Retinal fundus photograph — 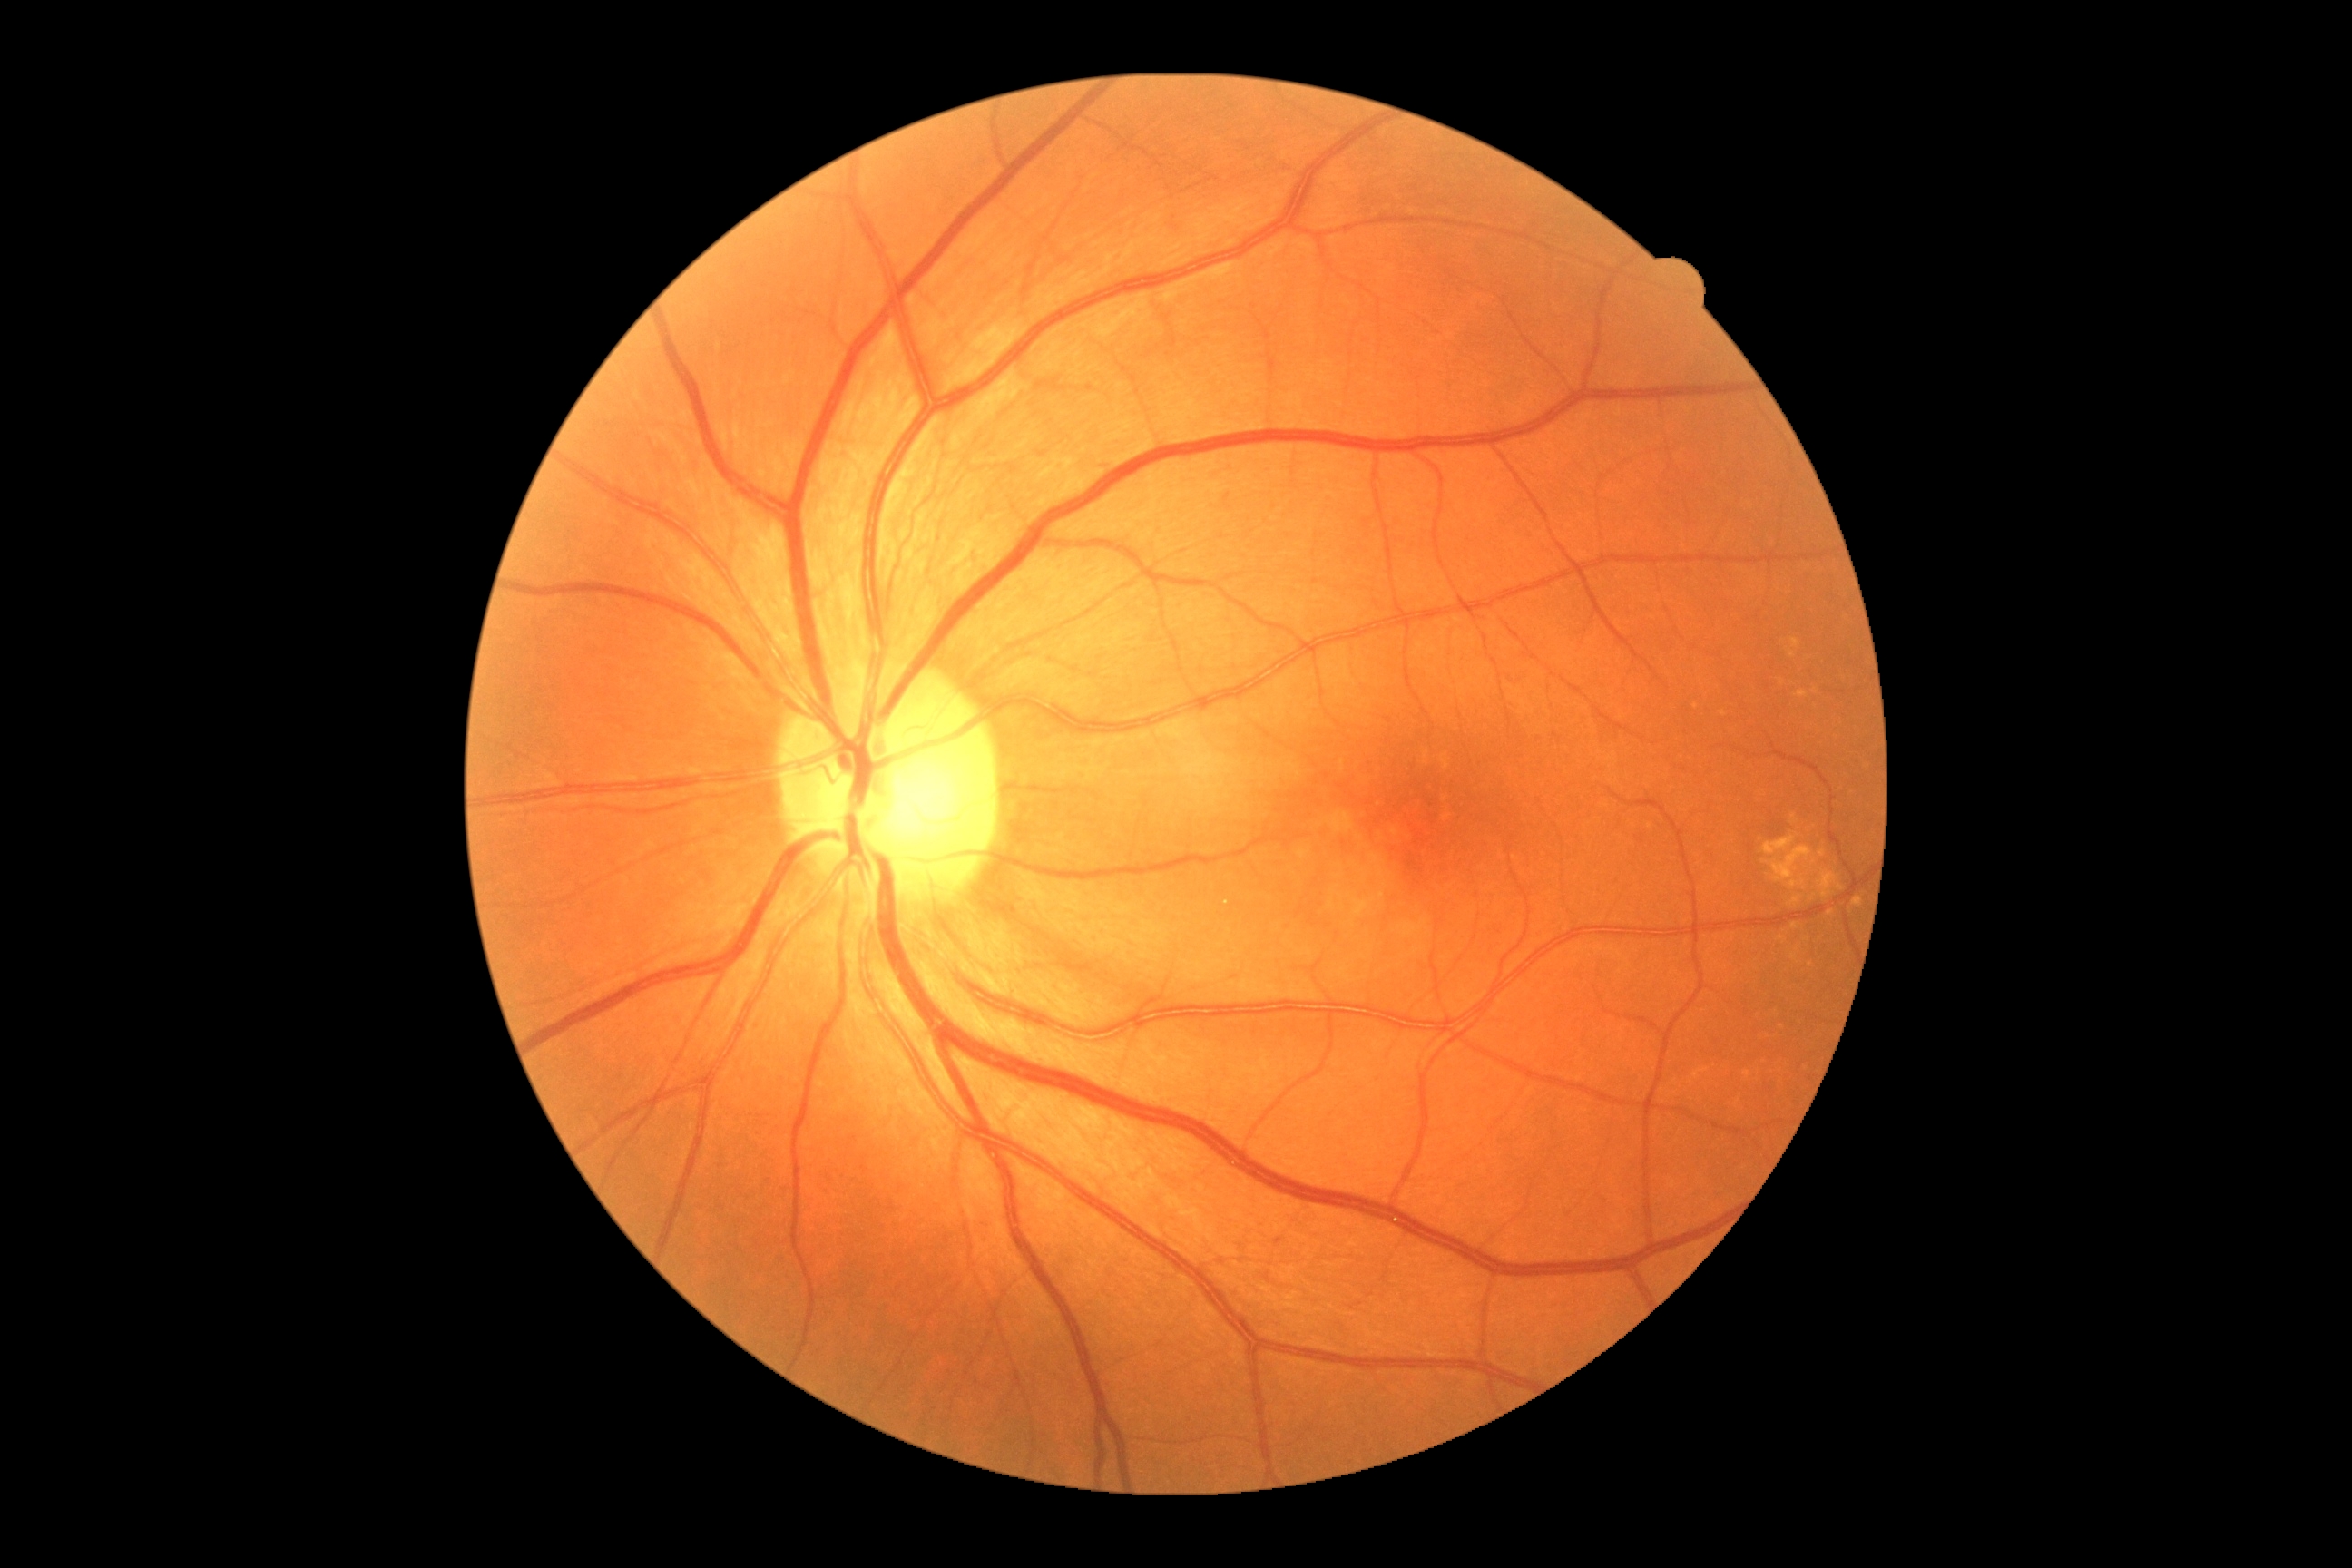

DR: grade 0 — no visible signs of diabetic retinopathy.